1240x1240 · wide-field fundus image from infant ROP screening — 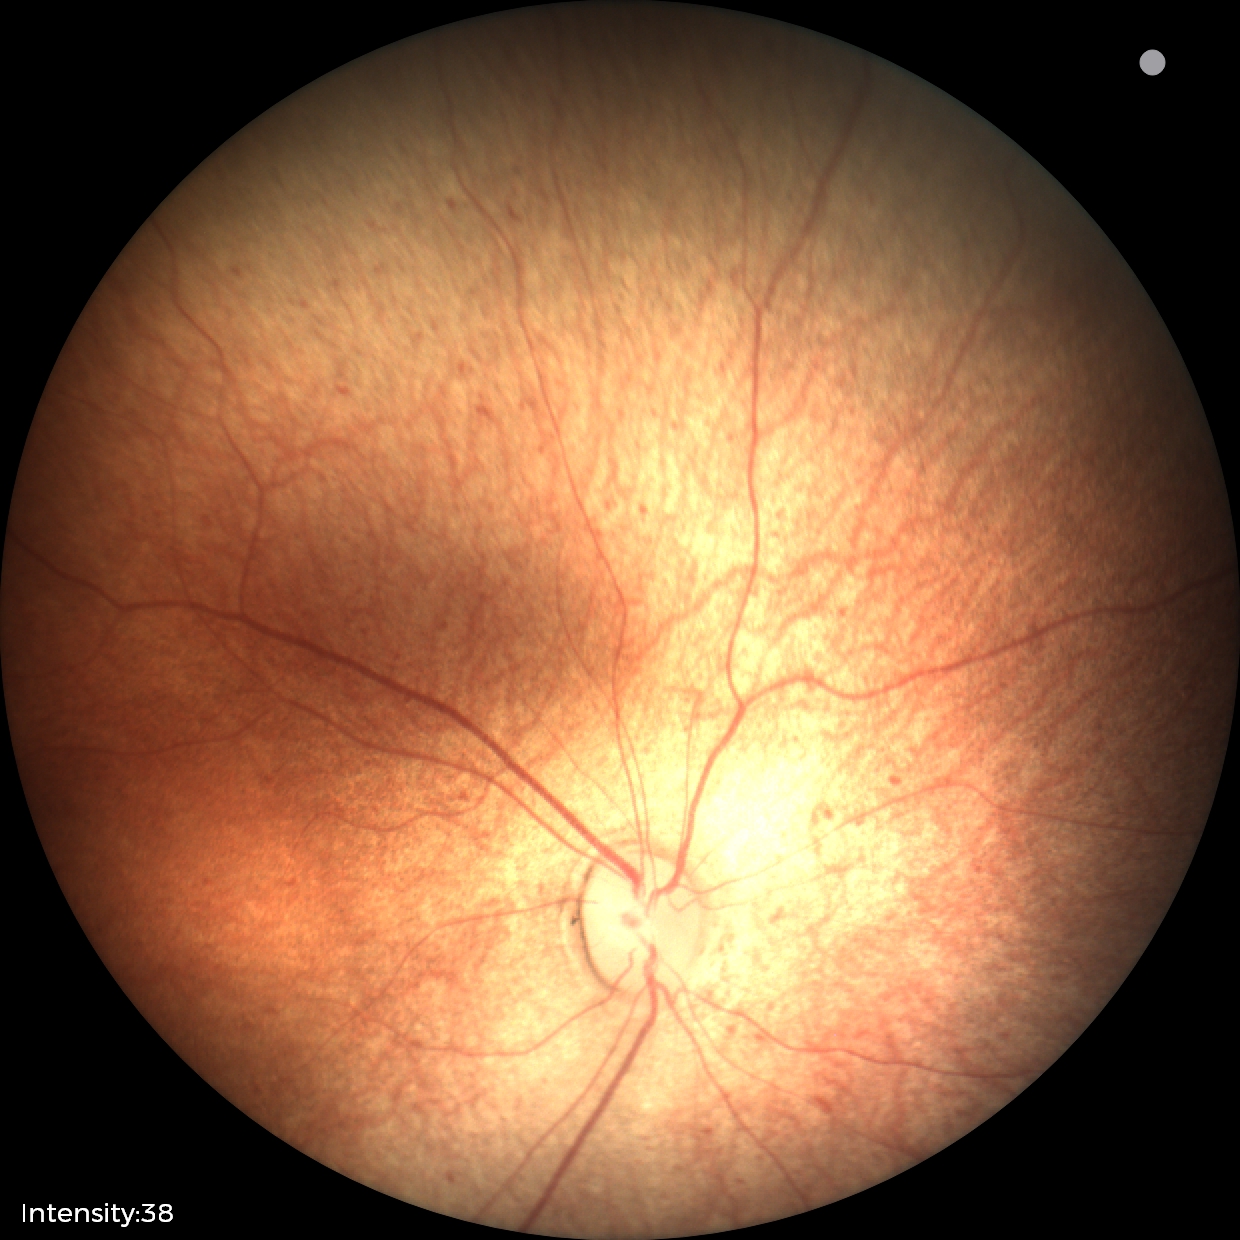
Assessment: normal fundus examination.